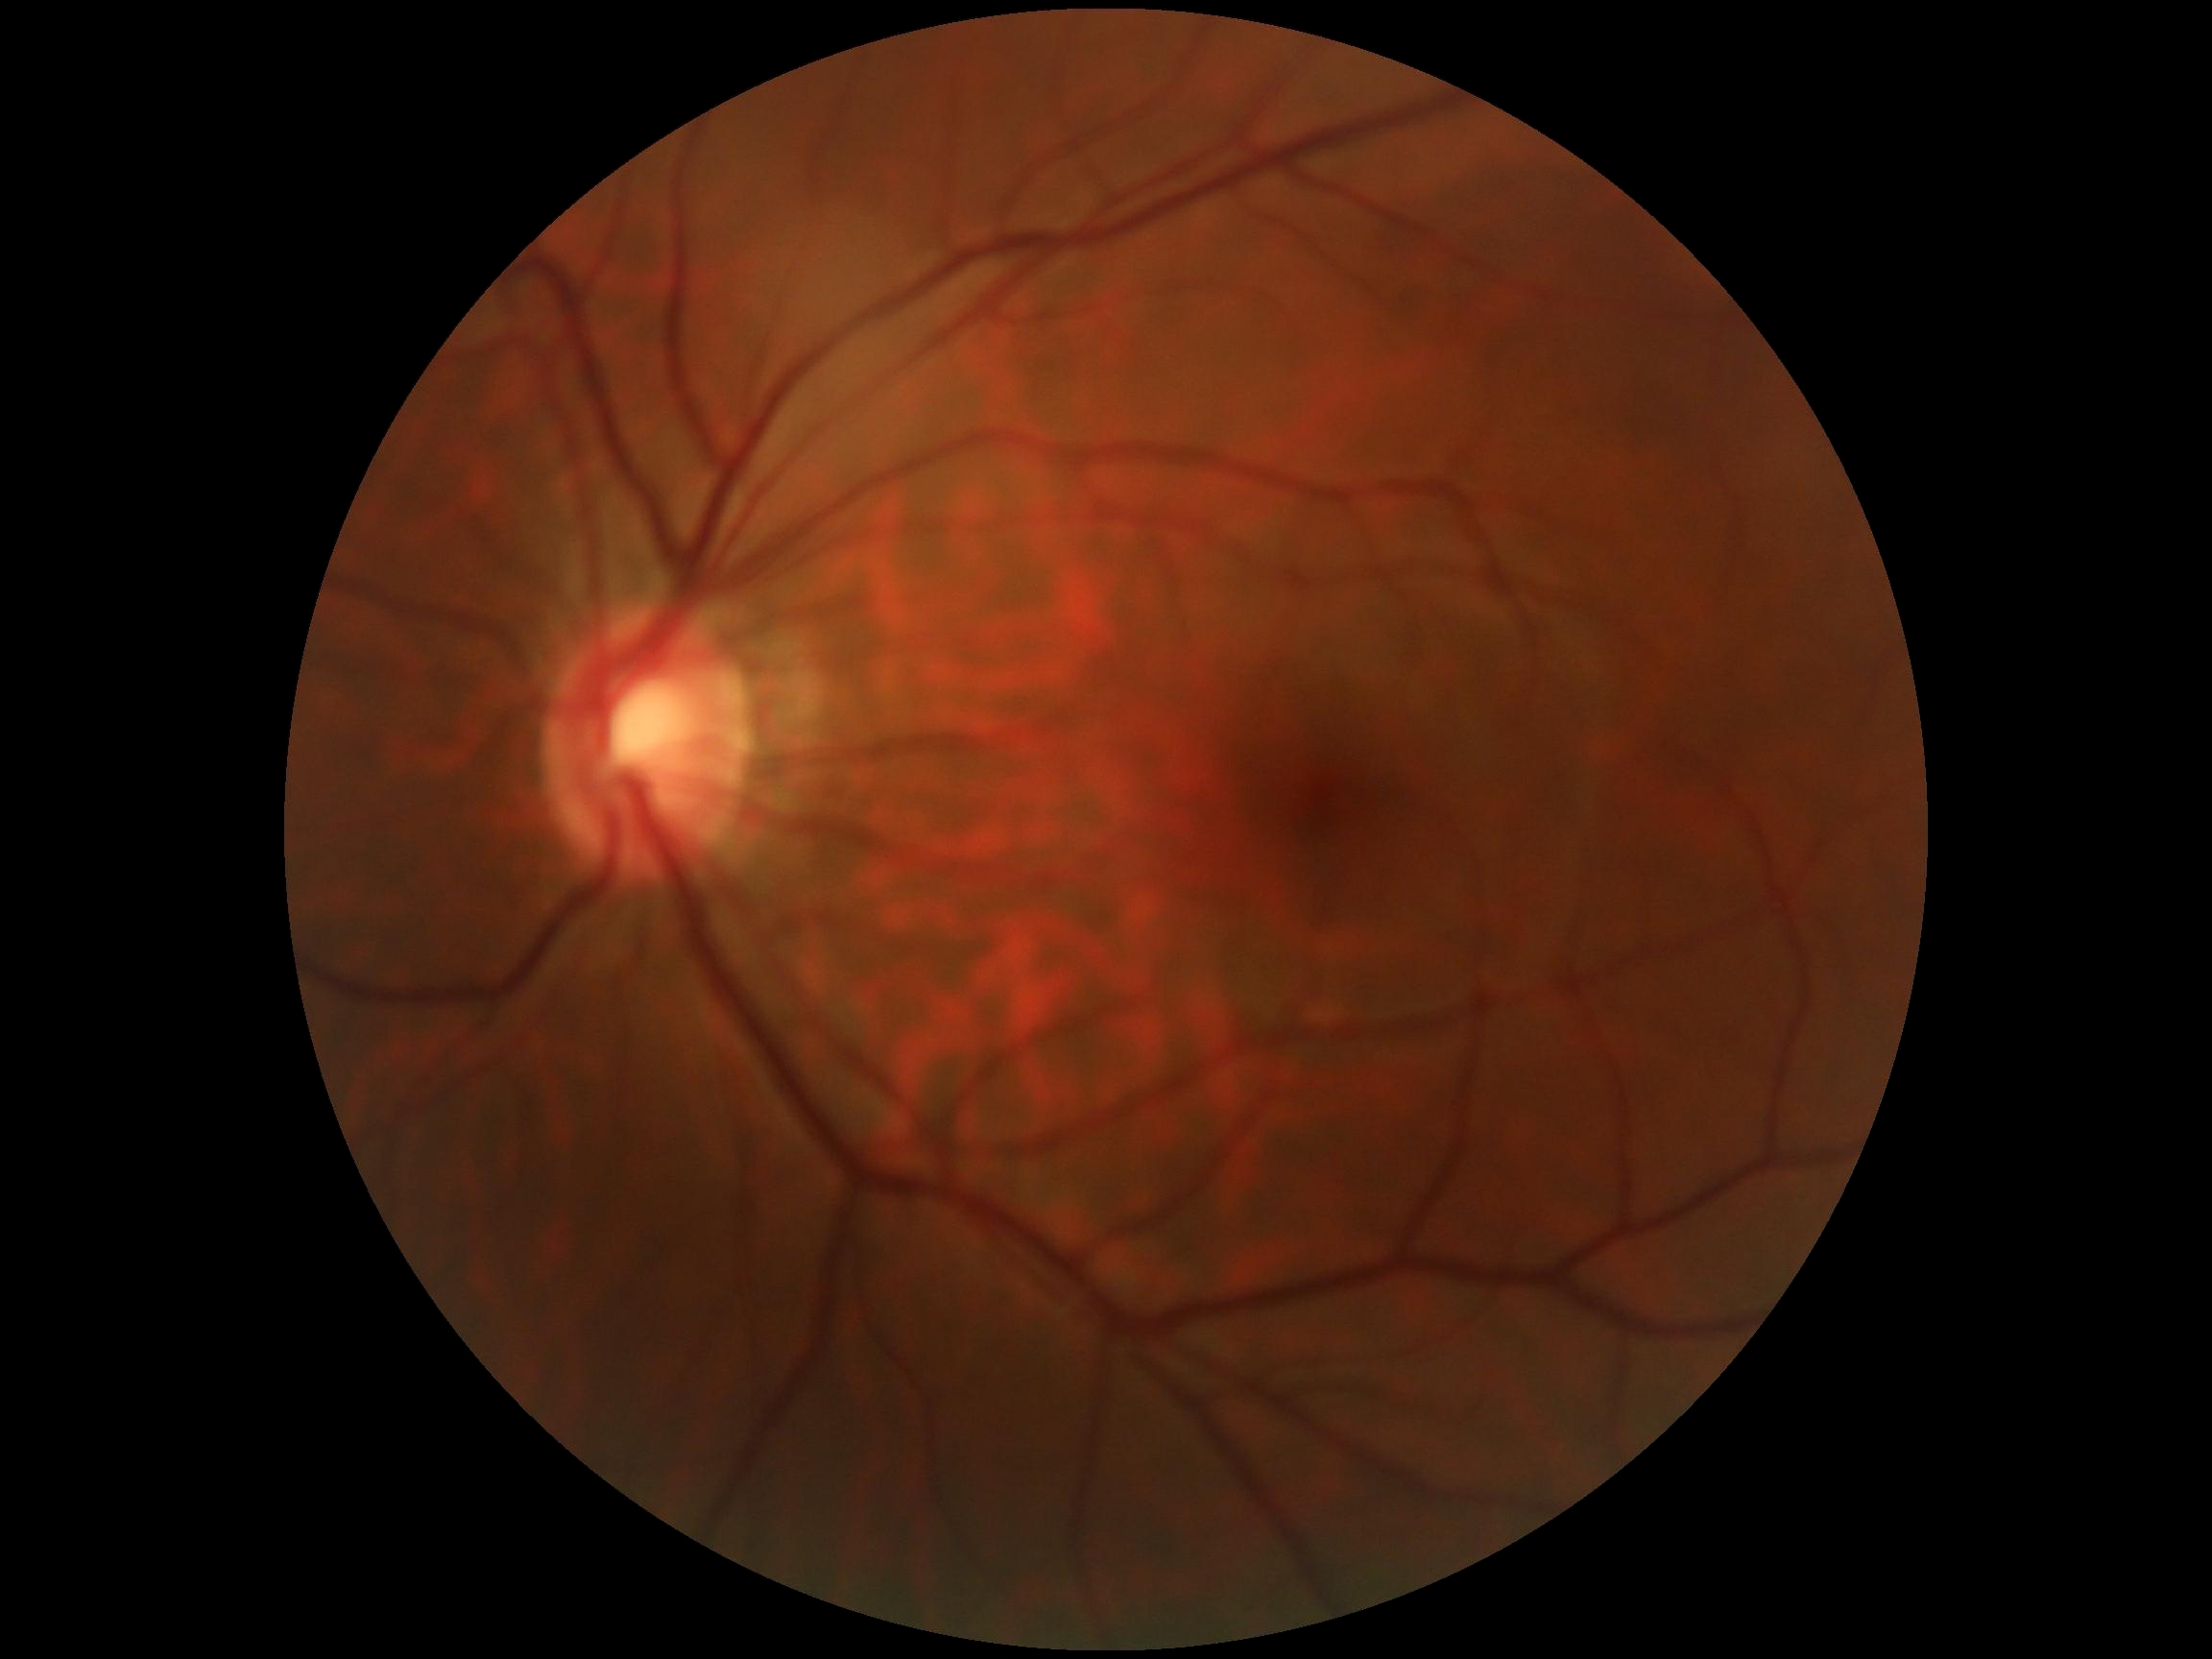

diabetic retinopathy = 0